1240 by 1240 pixels · infant wide-field fundus photograph:
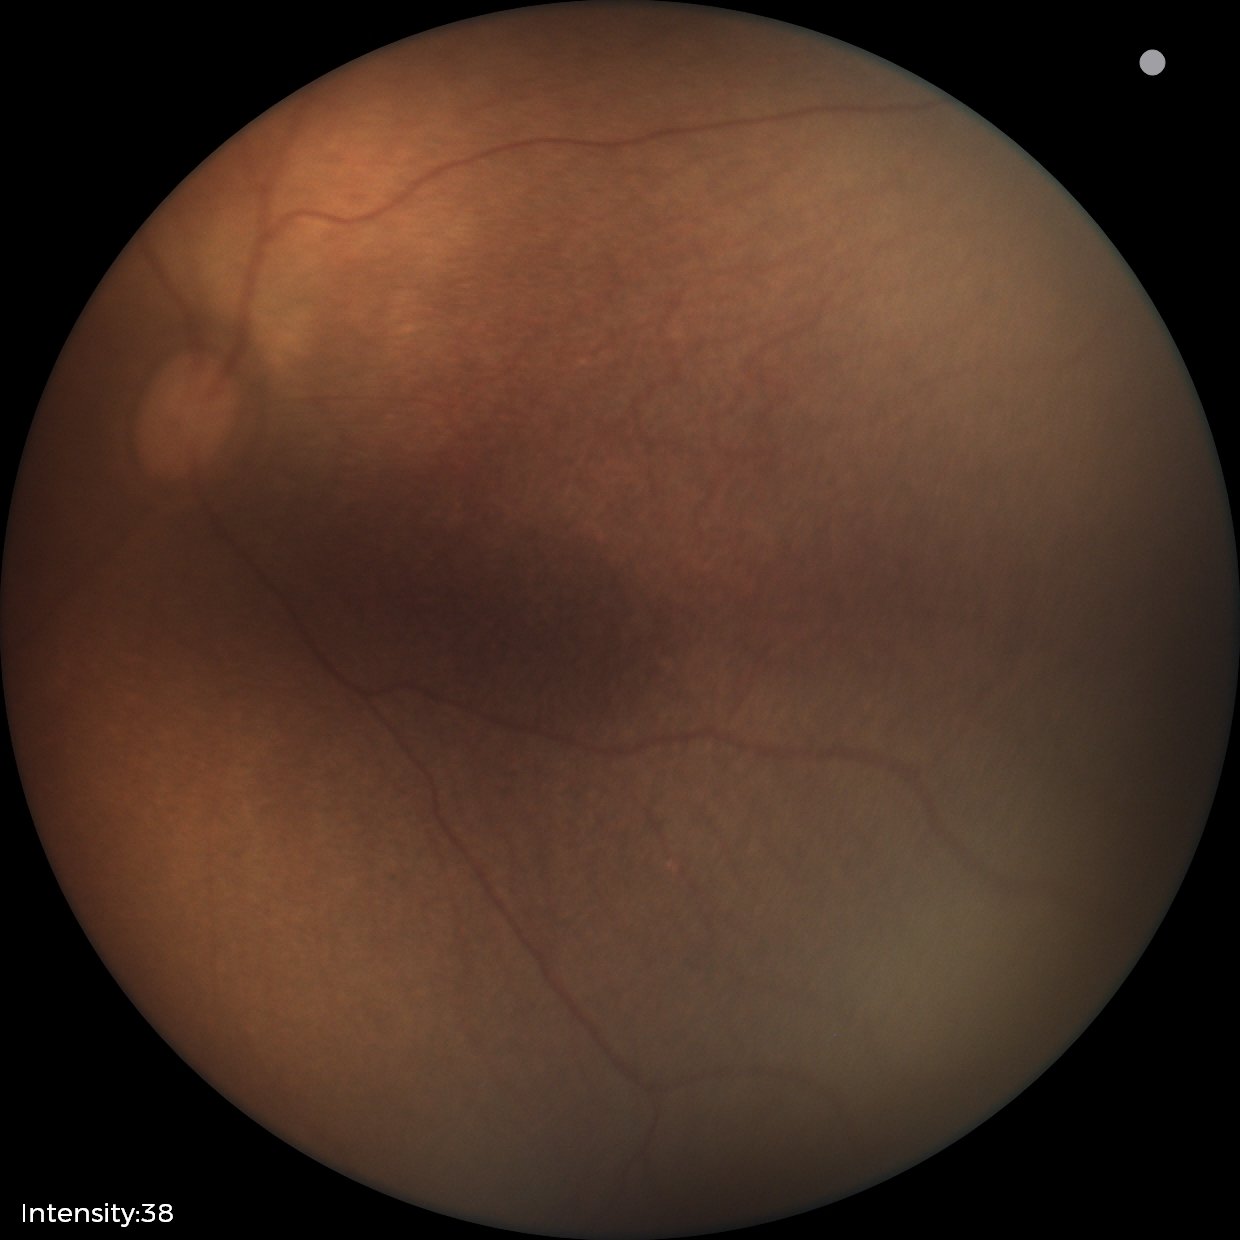

Assessment: physiological appearance with no retinal pathology.